45° field of view — 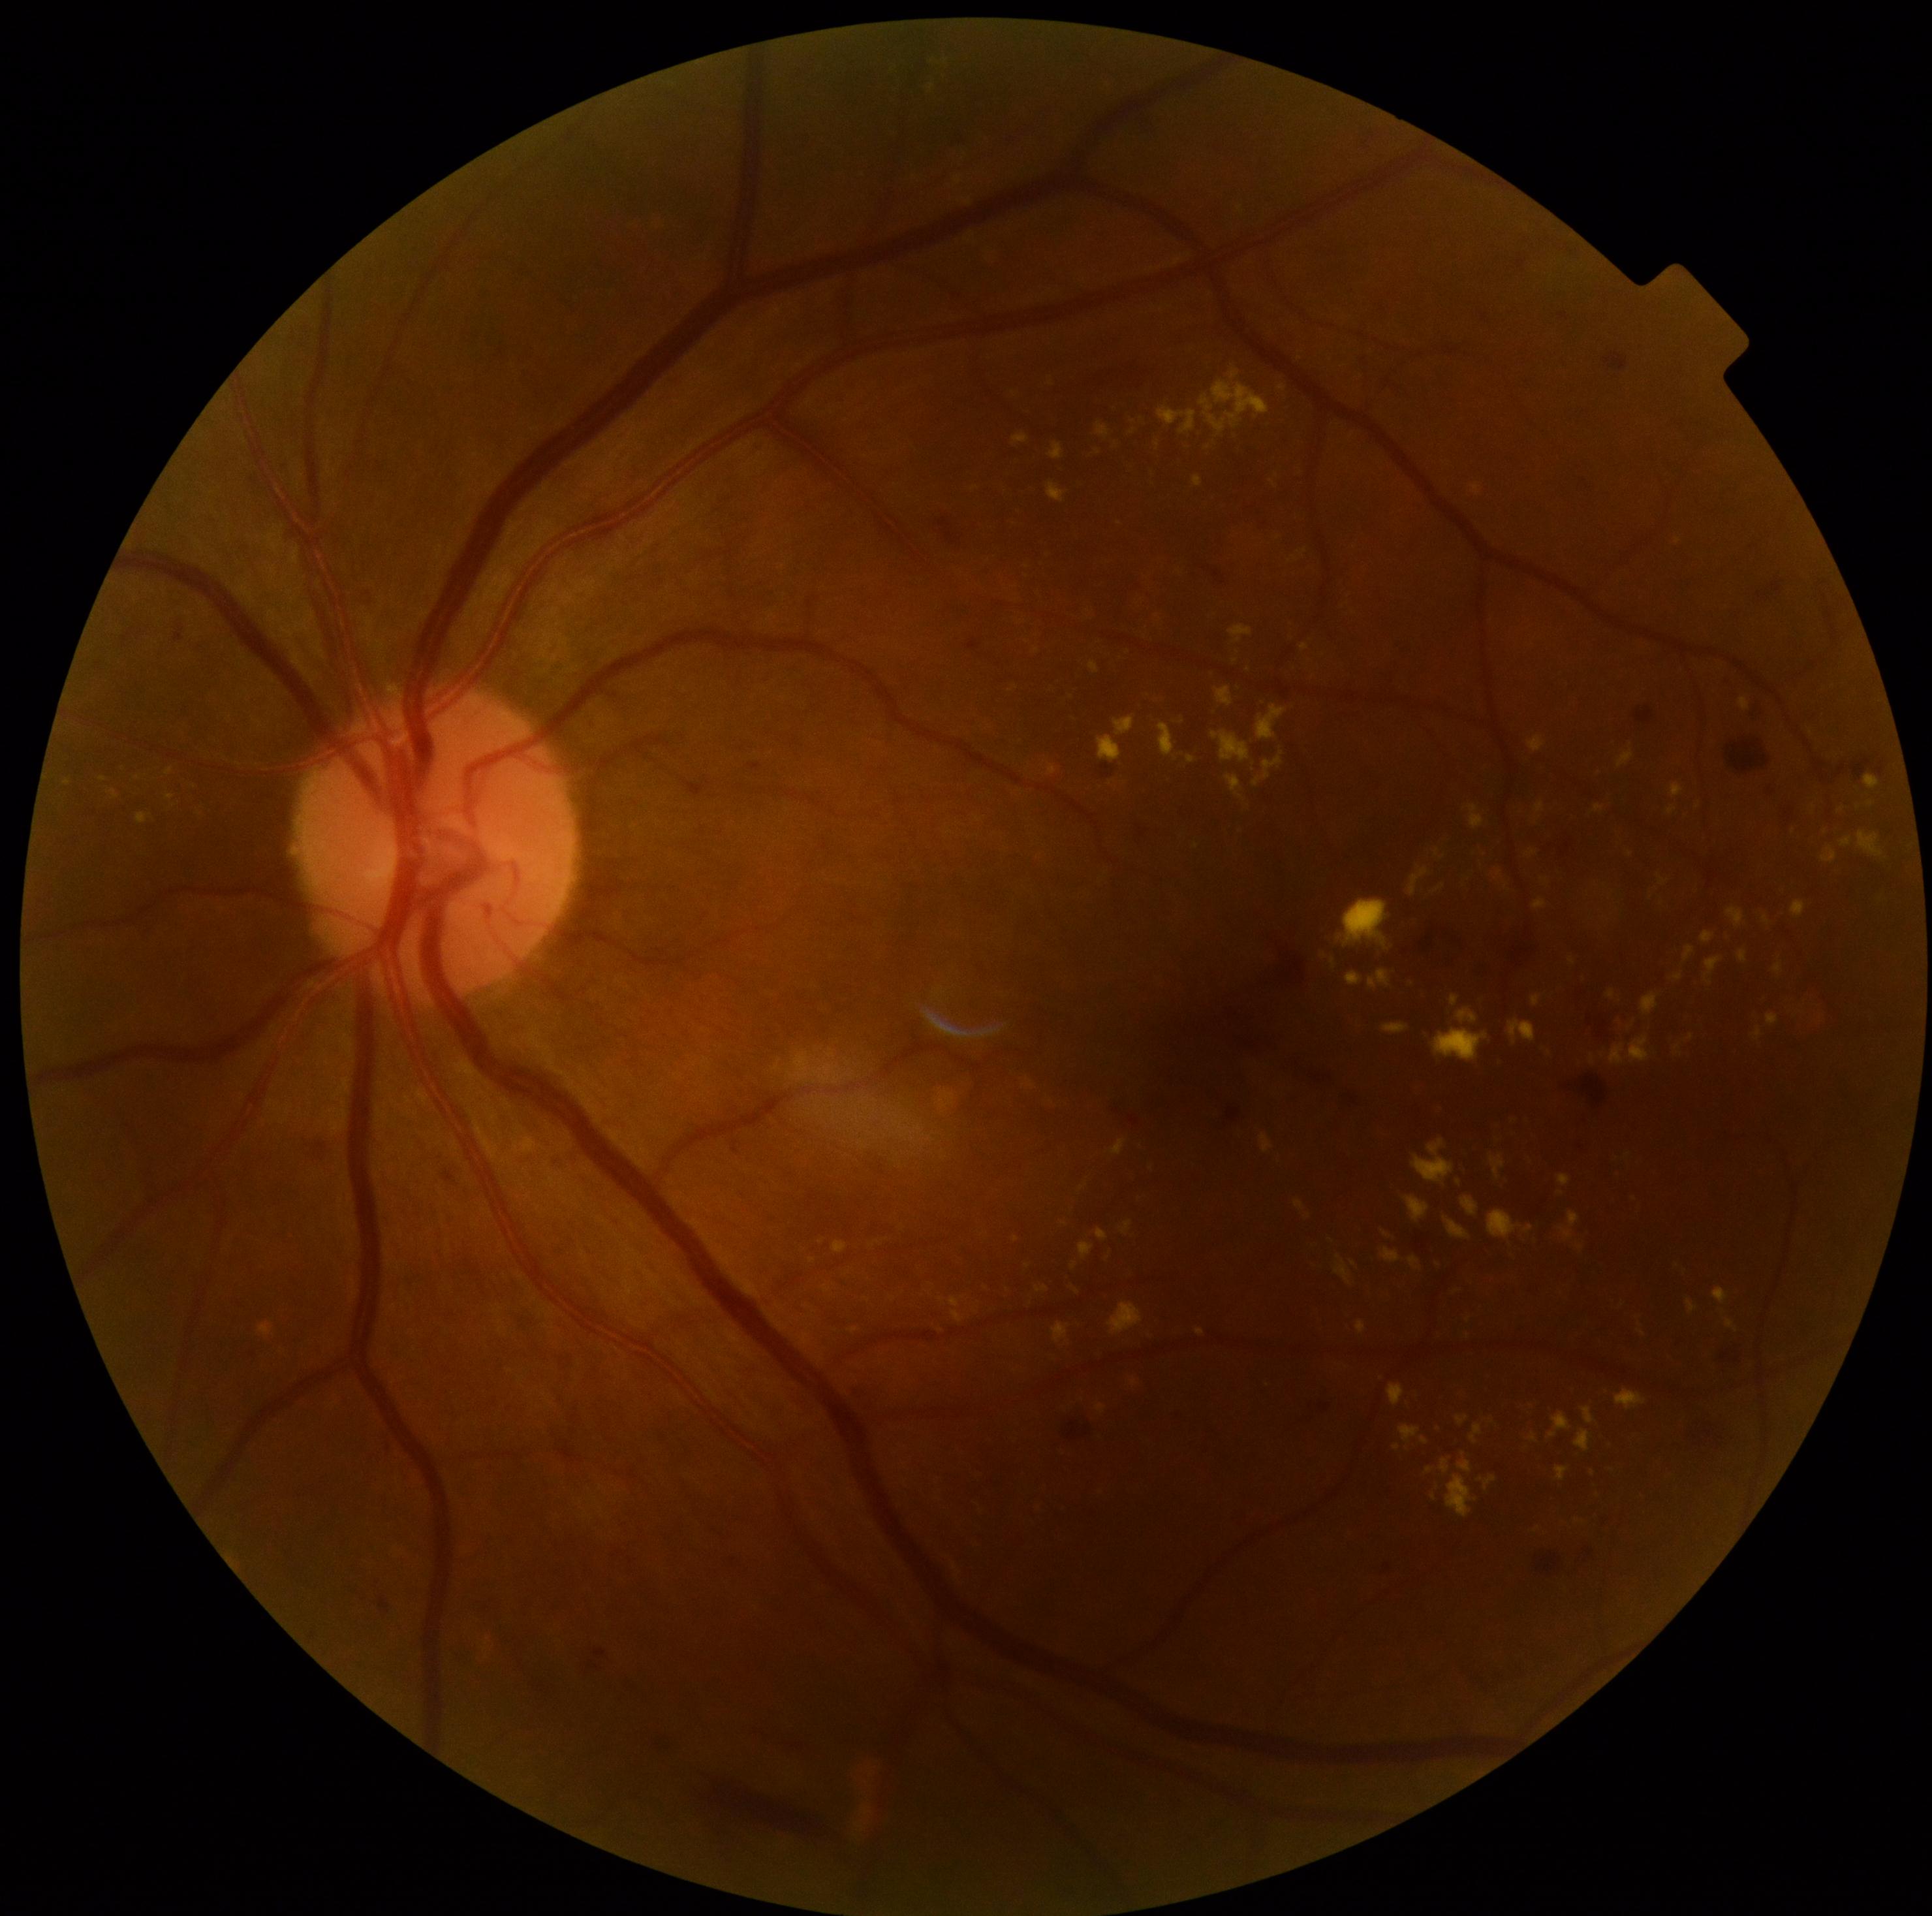
partial: true
dr_grade: 2
lesions:
  ex:
    - (left=1294, top=1200, right=1305, bottom=1212)
    - (left=1609, top=1043, right=1626, bottom=1065)
    - (left=165, top=794, right=176, bottom=802)
    - (left=1421, top=1437, right=1430, bottom=1444)
    - (left=1048, top=482, right=1067, bottom=503)
    - (left=1700, top=932, right=1716, bottom=945)
    - (left=1112, top=1139, right=1126, bottom=1155)
    - (left=1524, top=1225, right=1535, bottom=1234)
    - (left=1253, top=751, right=1285, bottom=789)
    - (left=1409, top=867, right=1430, bottom=897)
    - (left=1618, top=751, right=1635, bottom=768)
    - (left=1535, top=802, right=1546, bottom=815)
  ex_small:
    - Point(1679, 541)
    - Point(942, 1299)
    - Point(1296, 559)
    - Point(1437, 1488)
    - Point(1064, 1223)
    - Point(1082, 1188)